Captured with the Natus RetCam Envision (130° field of view) · image size 1440x1080 · infant wide-field retinal image.
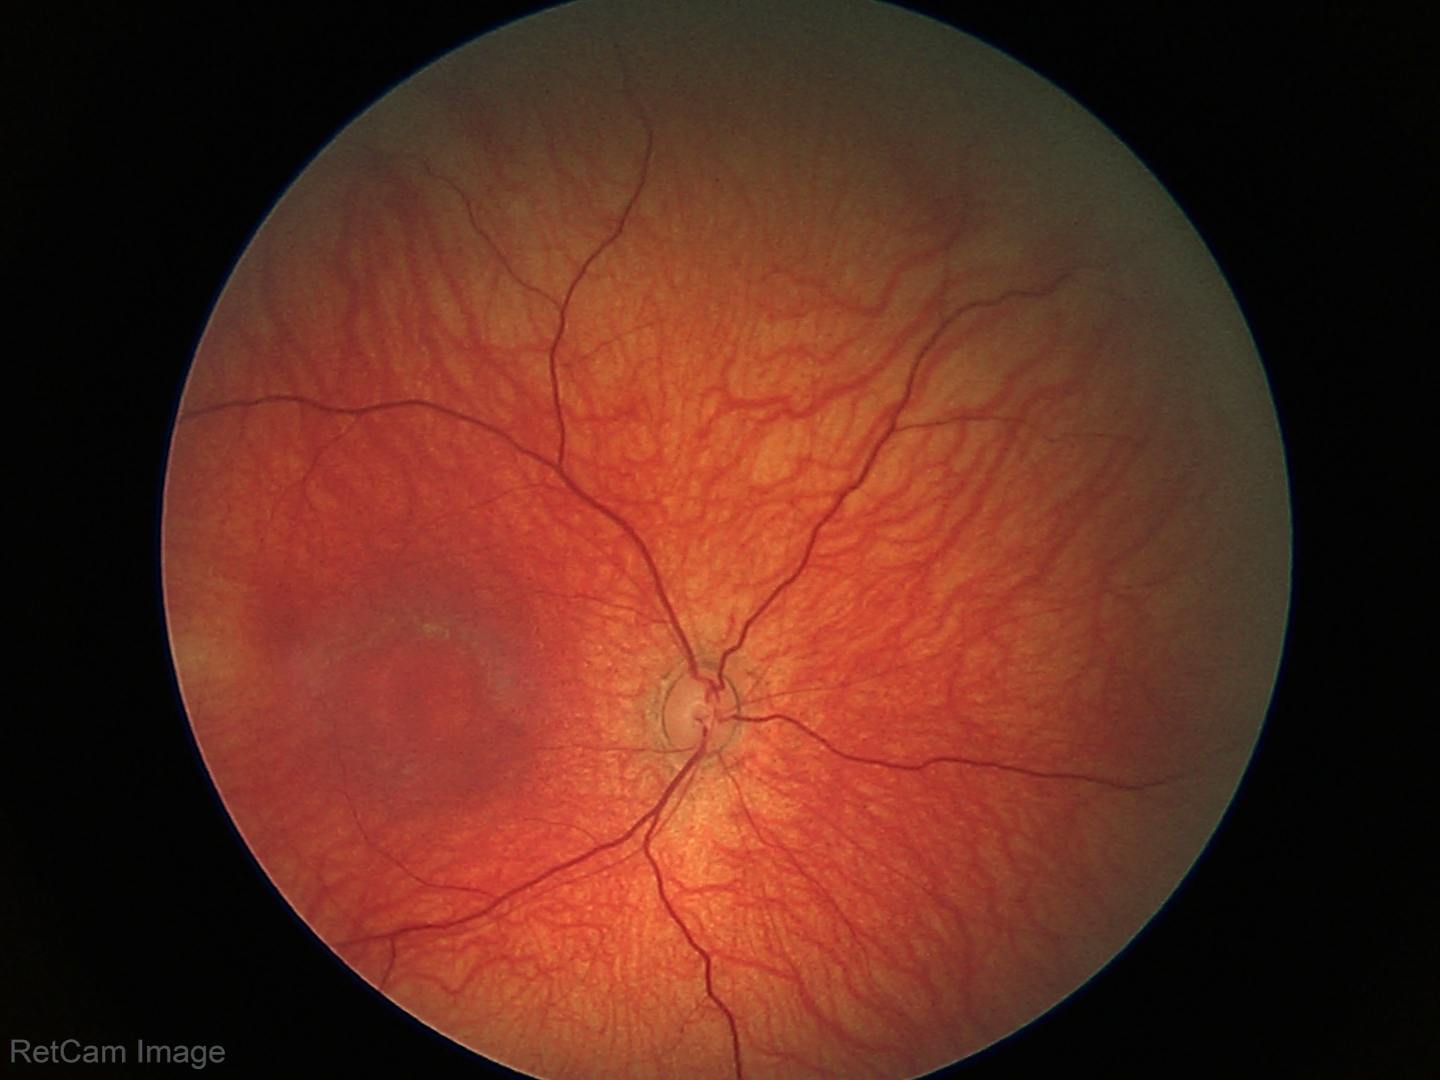

Normal screening examination.